50° FOV, dilated-pupil acquisition.
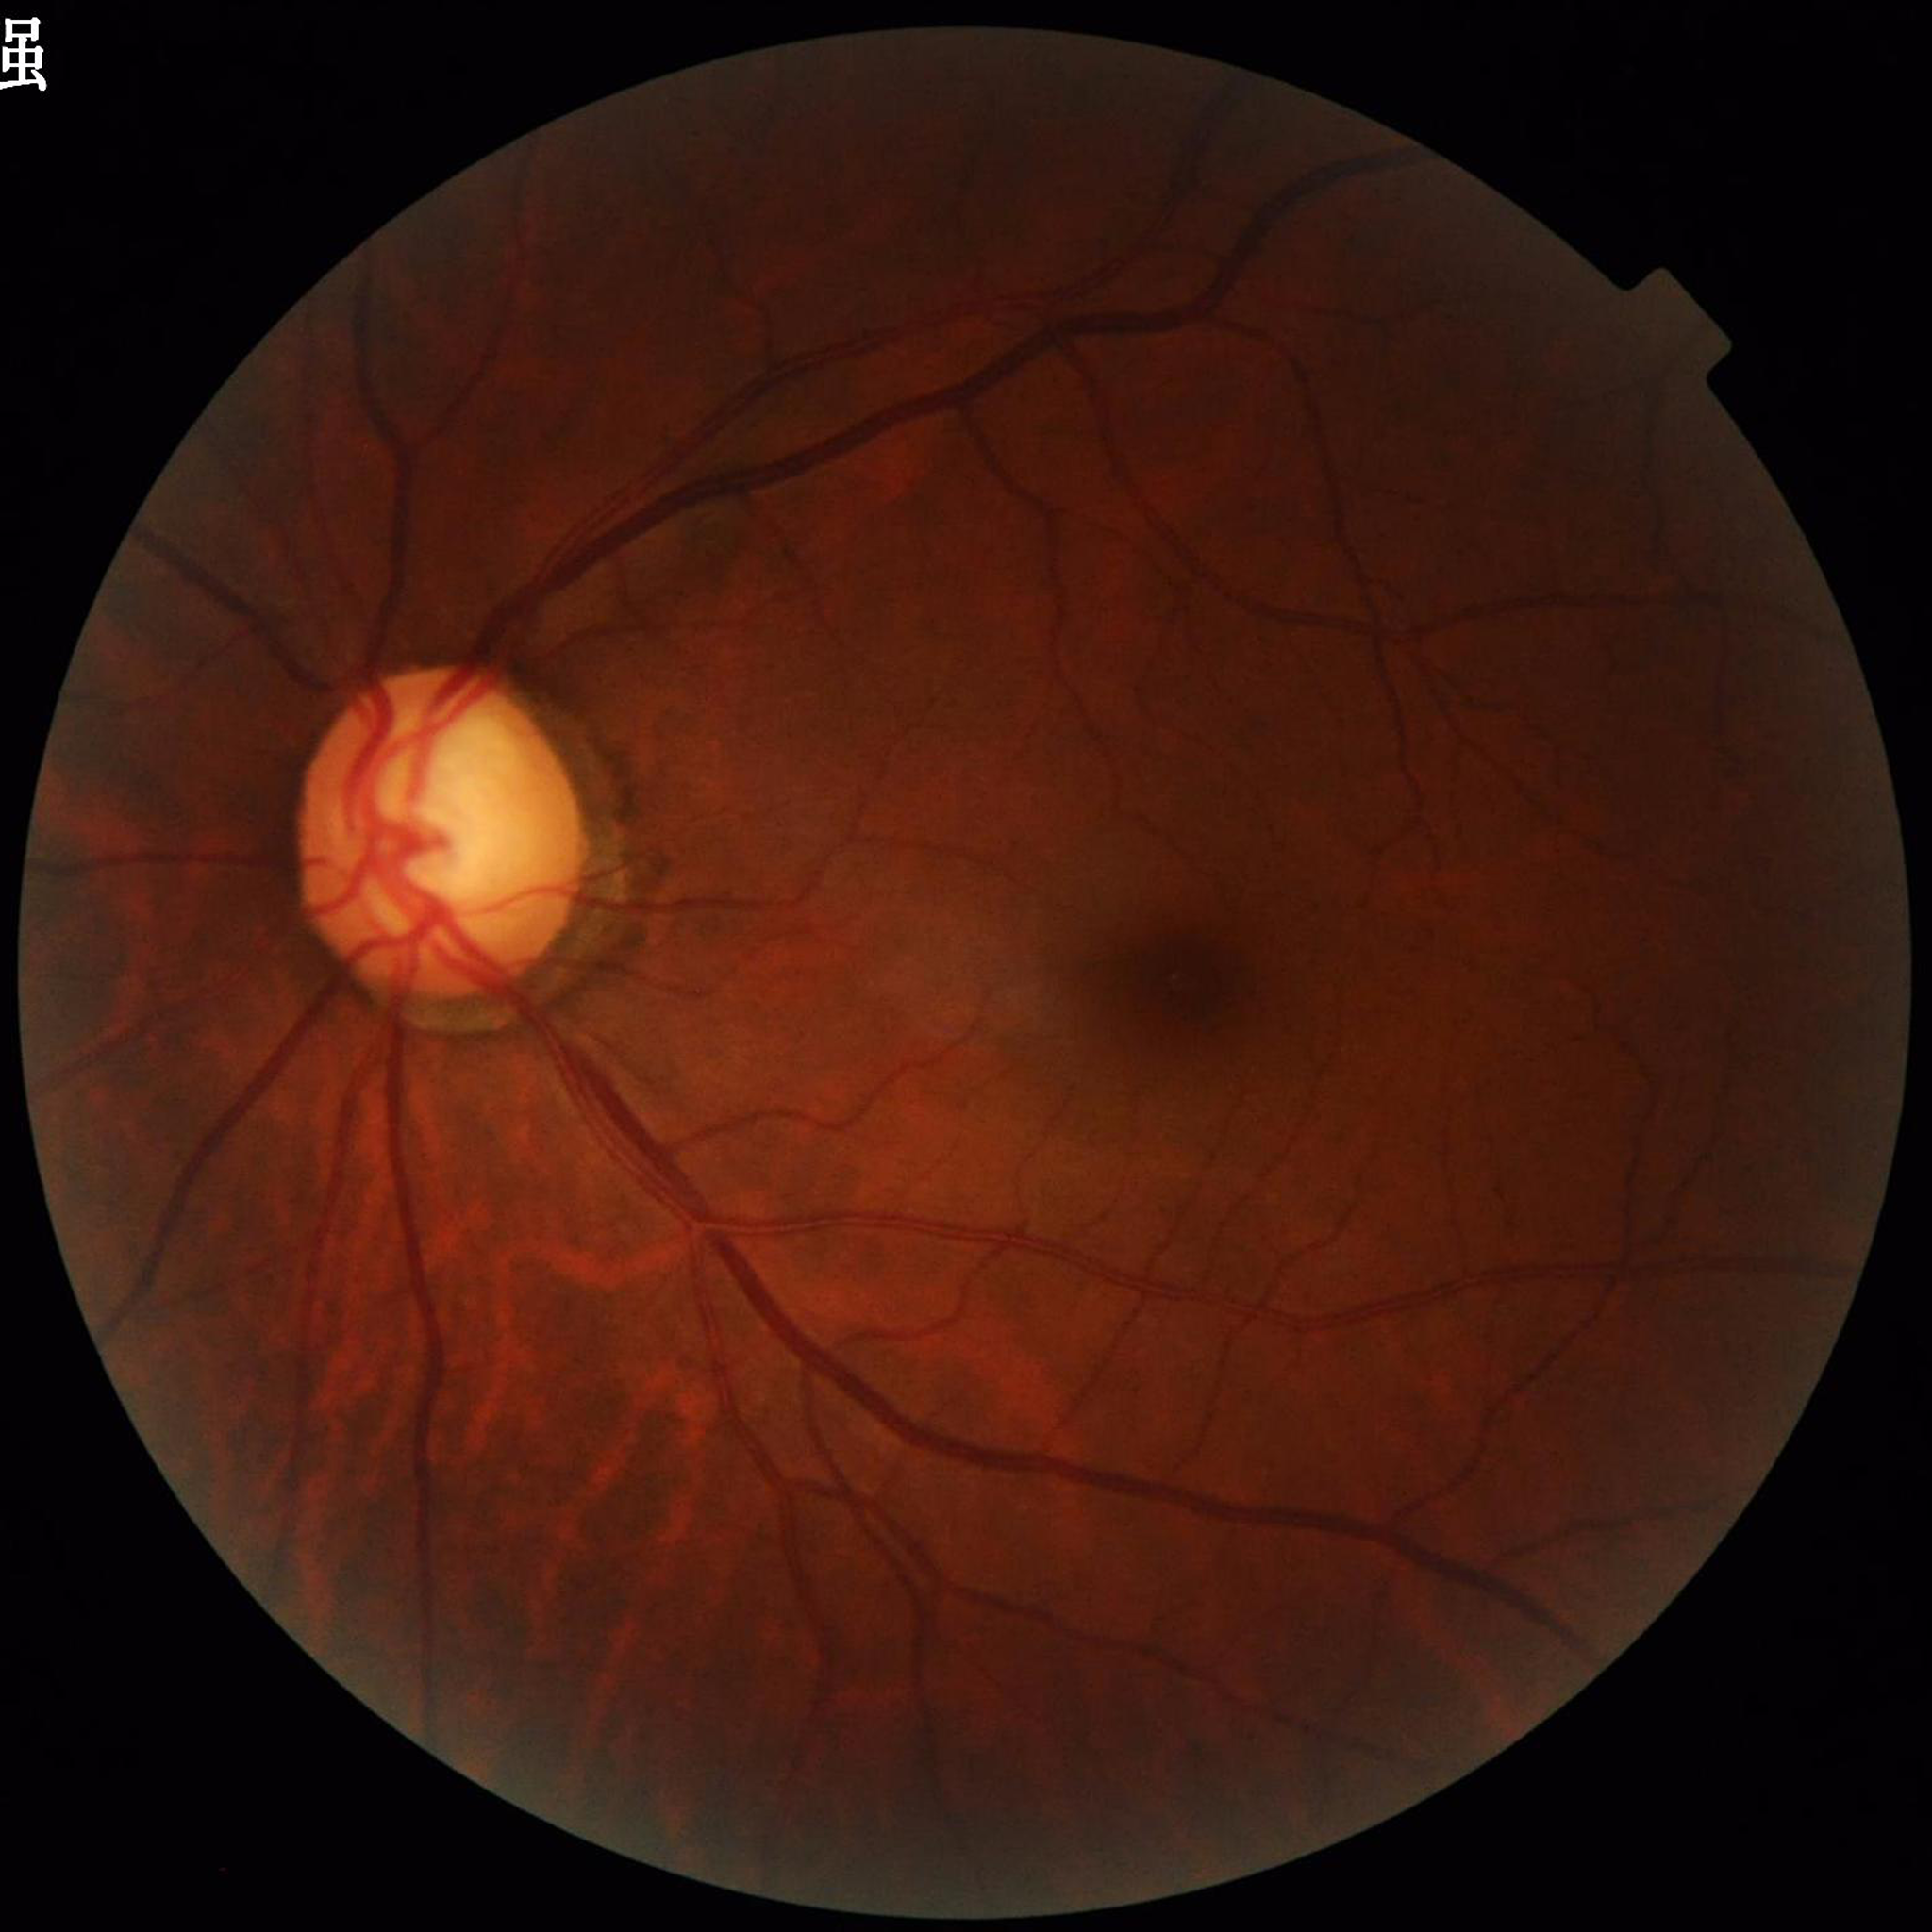

Fundus image of an eye with glaucoma.